640 x 480 pixels; wide-field fundus photograph from neonatal ROP screening: 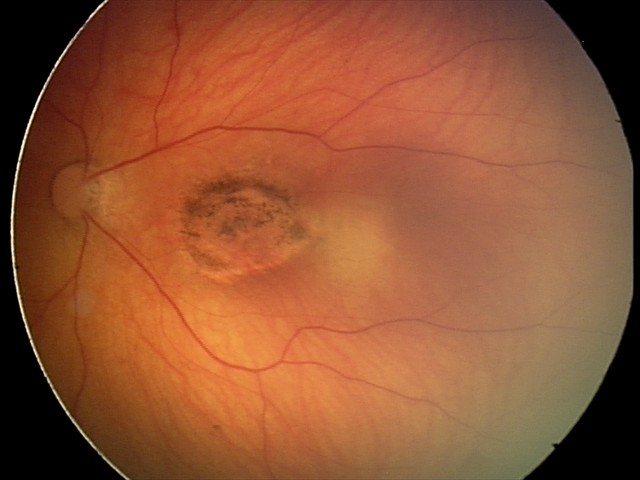

Q: What is the screening diagnosis?
A: toxoplasmosis chorioretinitis